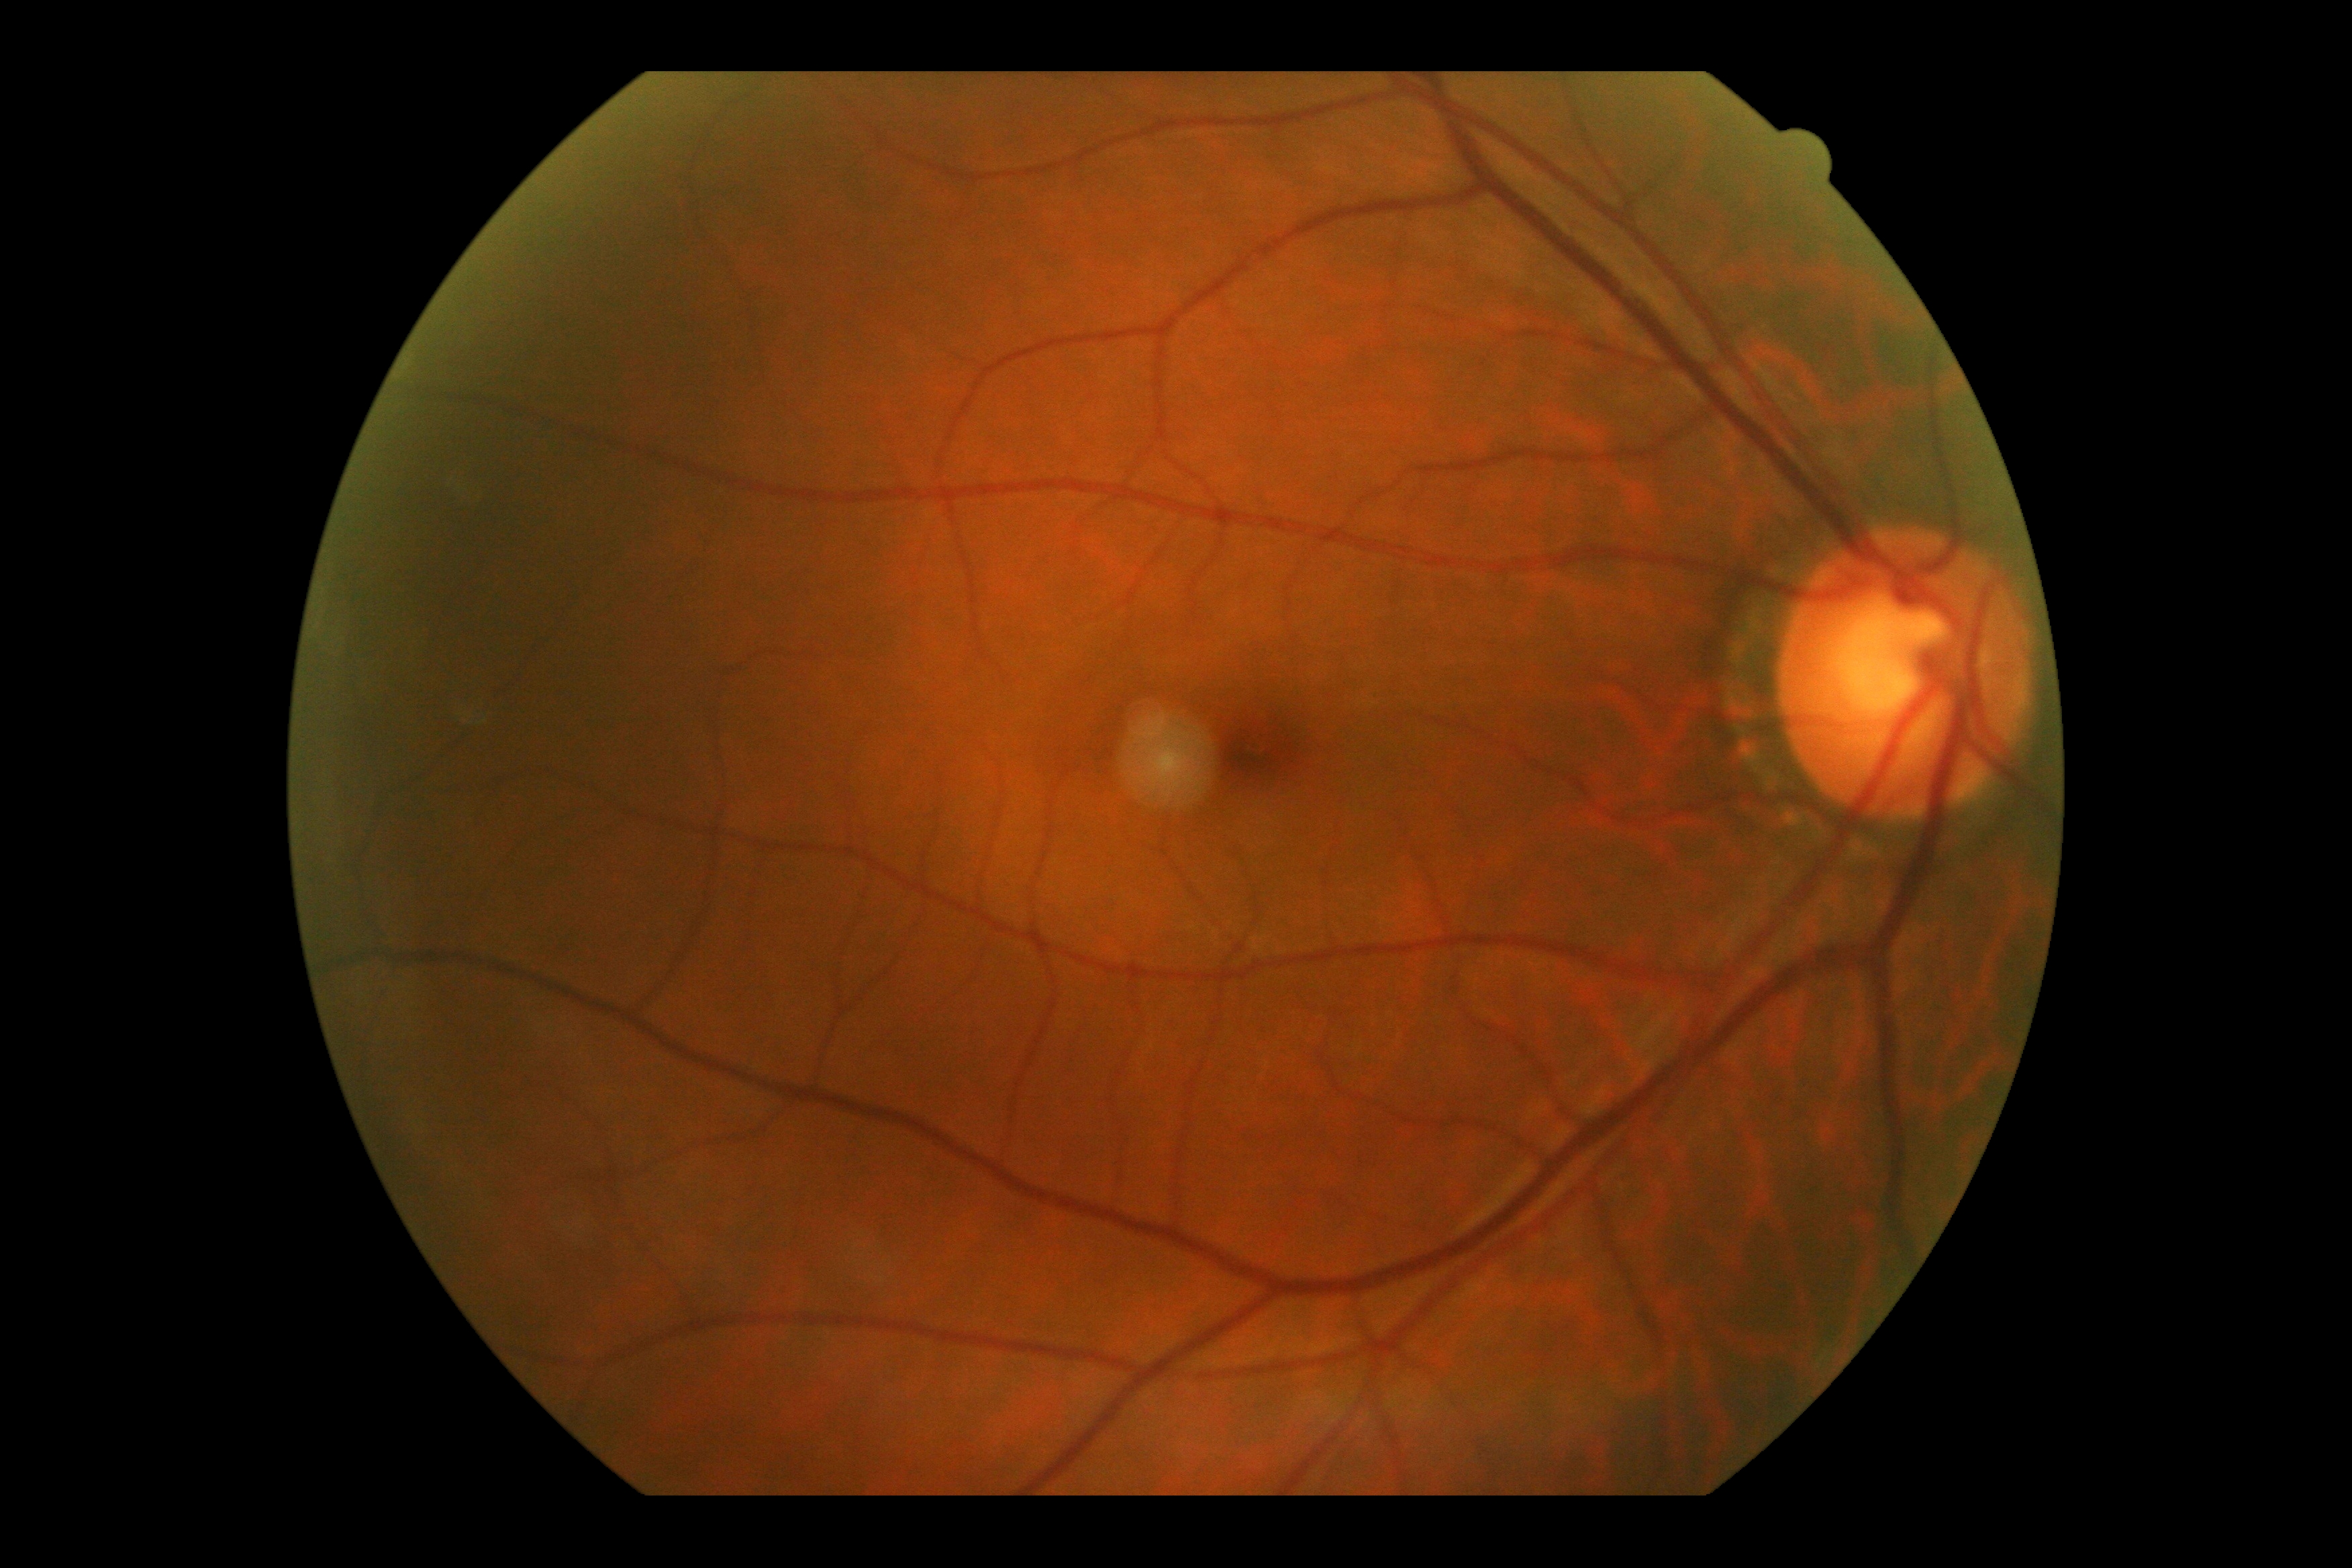

Retinopathy: no apparent diabetic retinopathy (grade 0).